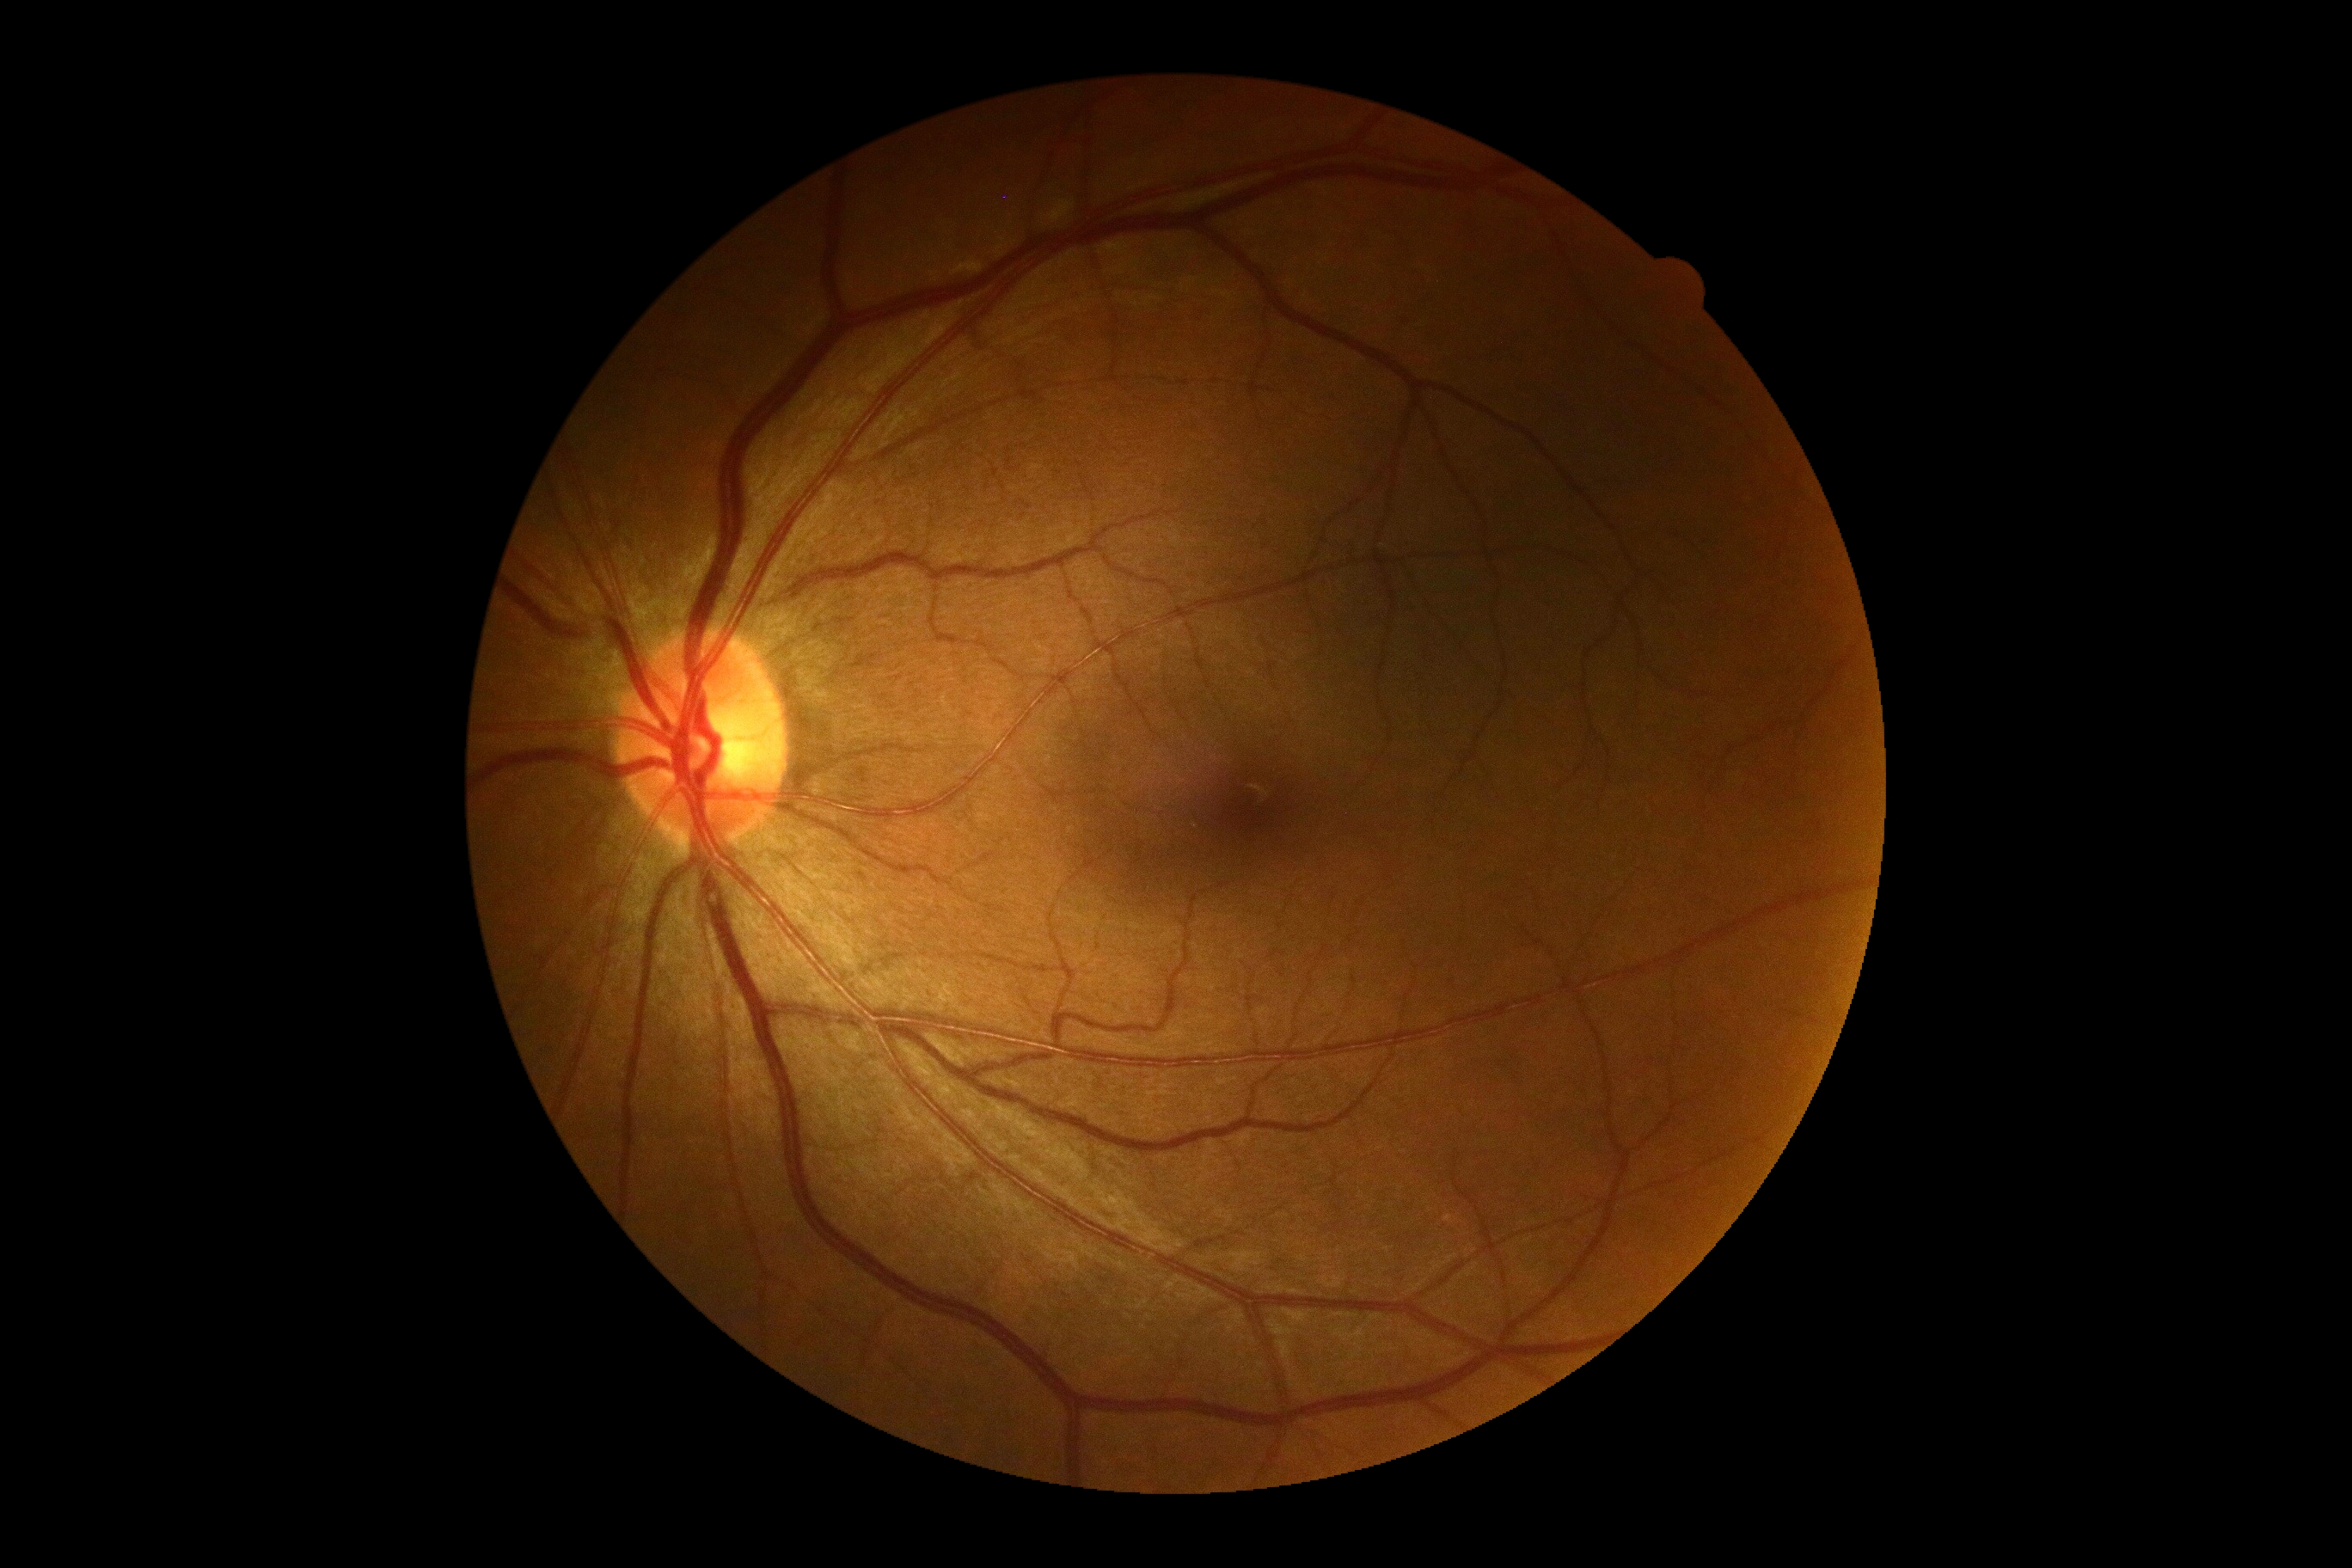
Diabetic retinopathy (DR): grade 0 (no apparent retinopathy) — no visible signs of diabetic retinopathy. No signs of diabetic retinopathy.